Color fundus image
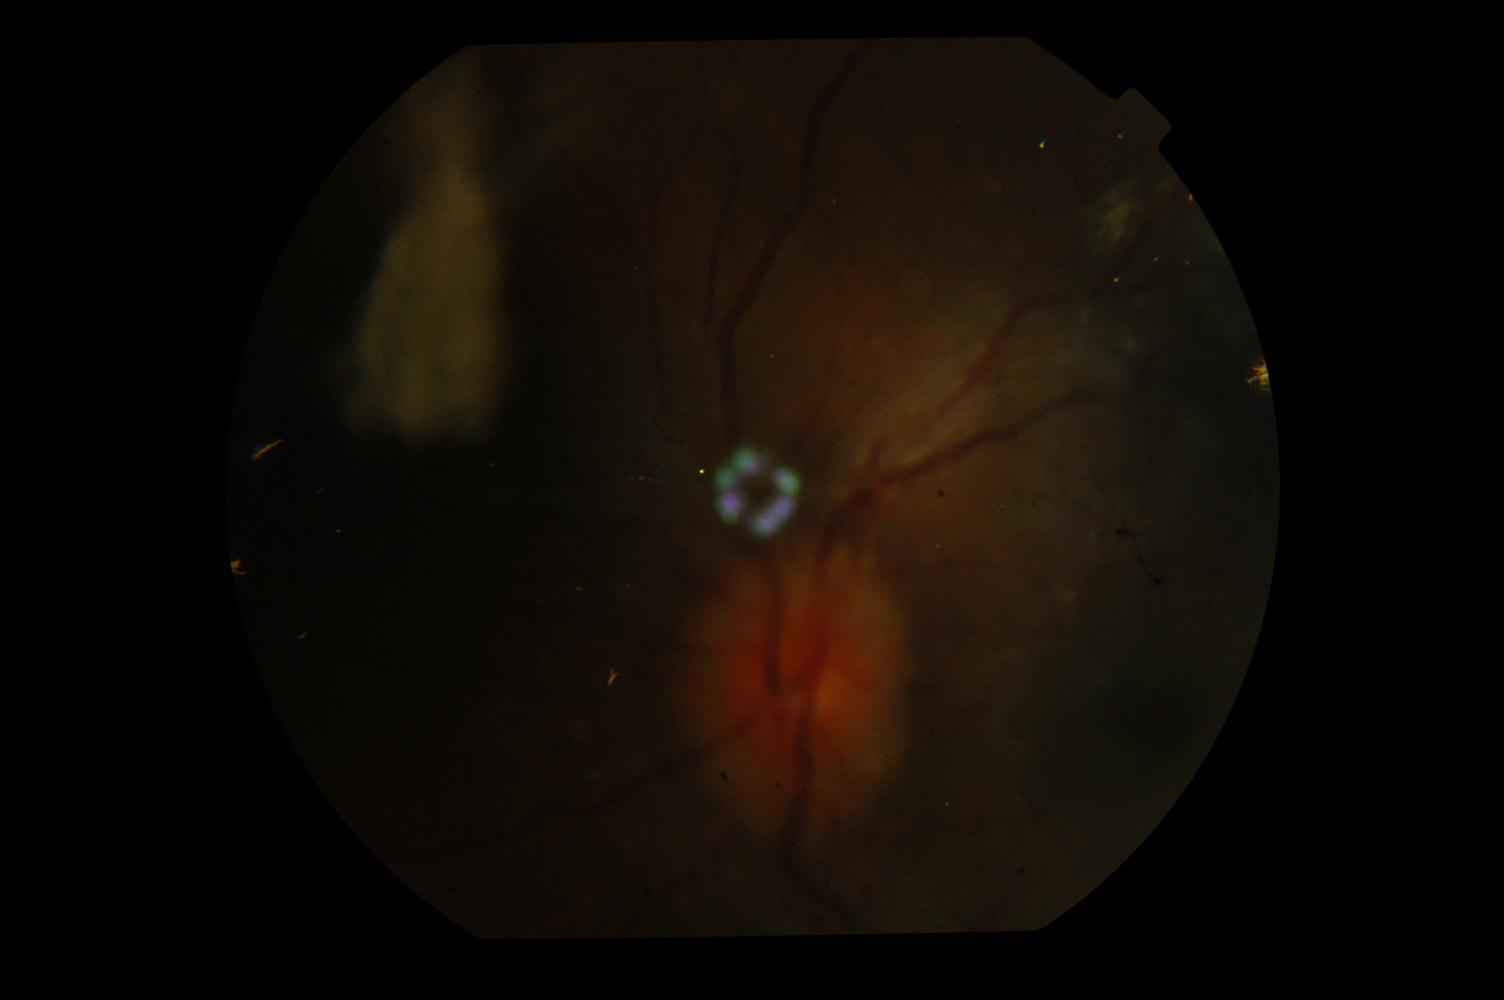 Diagnoses: idiopathic intracranial hypertension.